2352x1568:
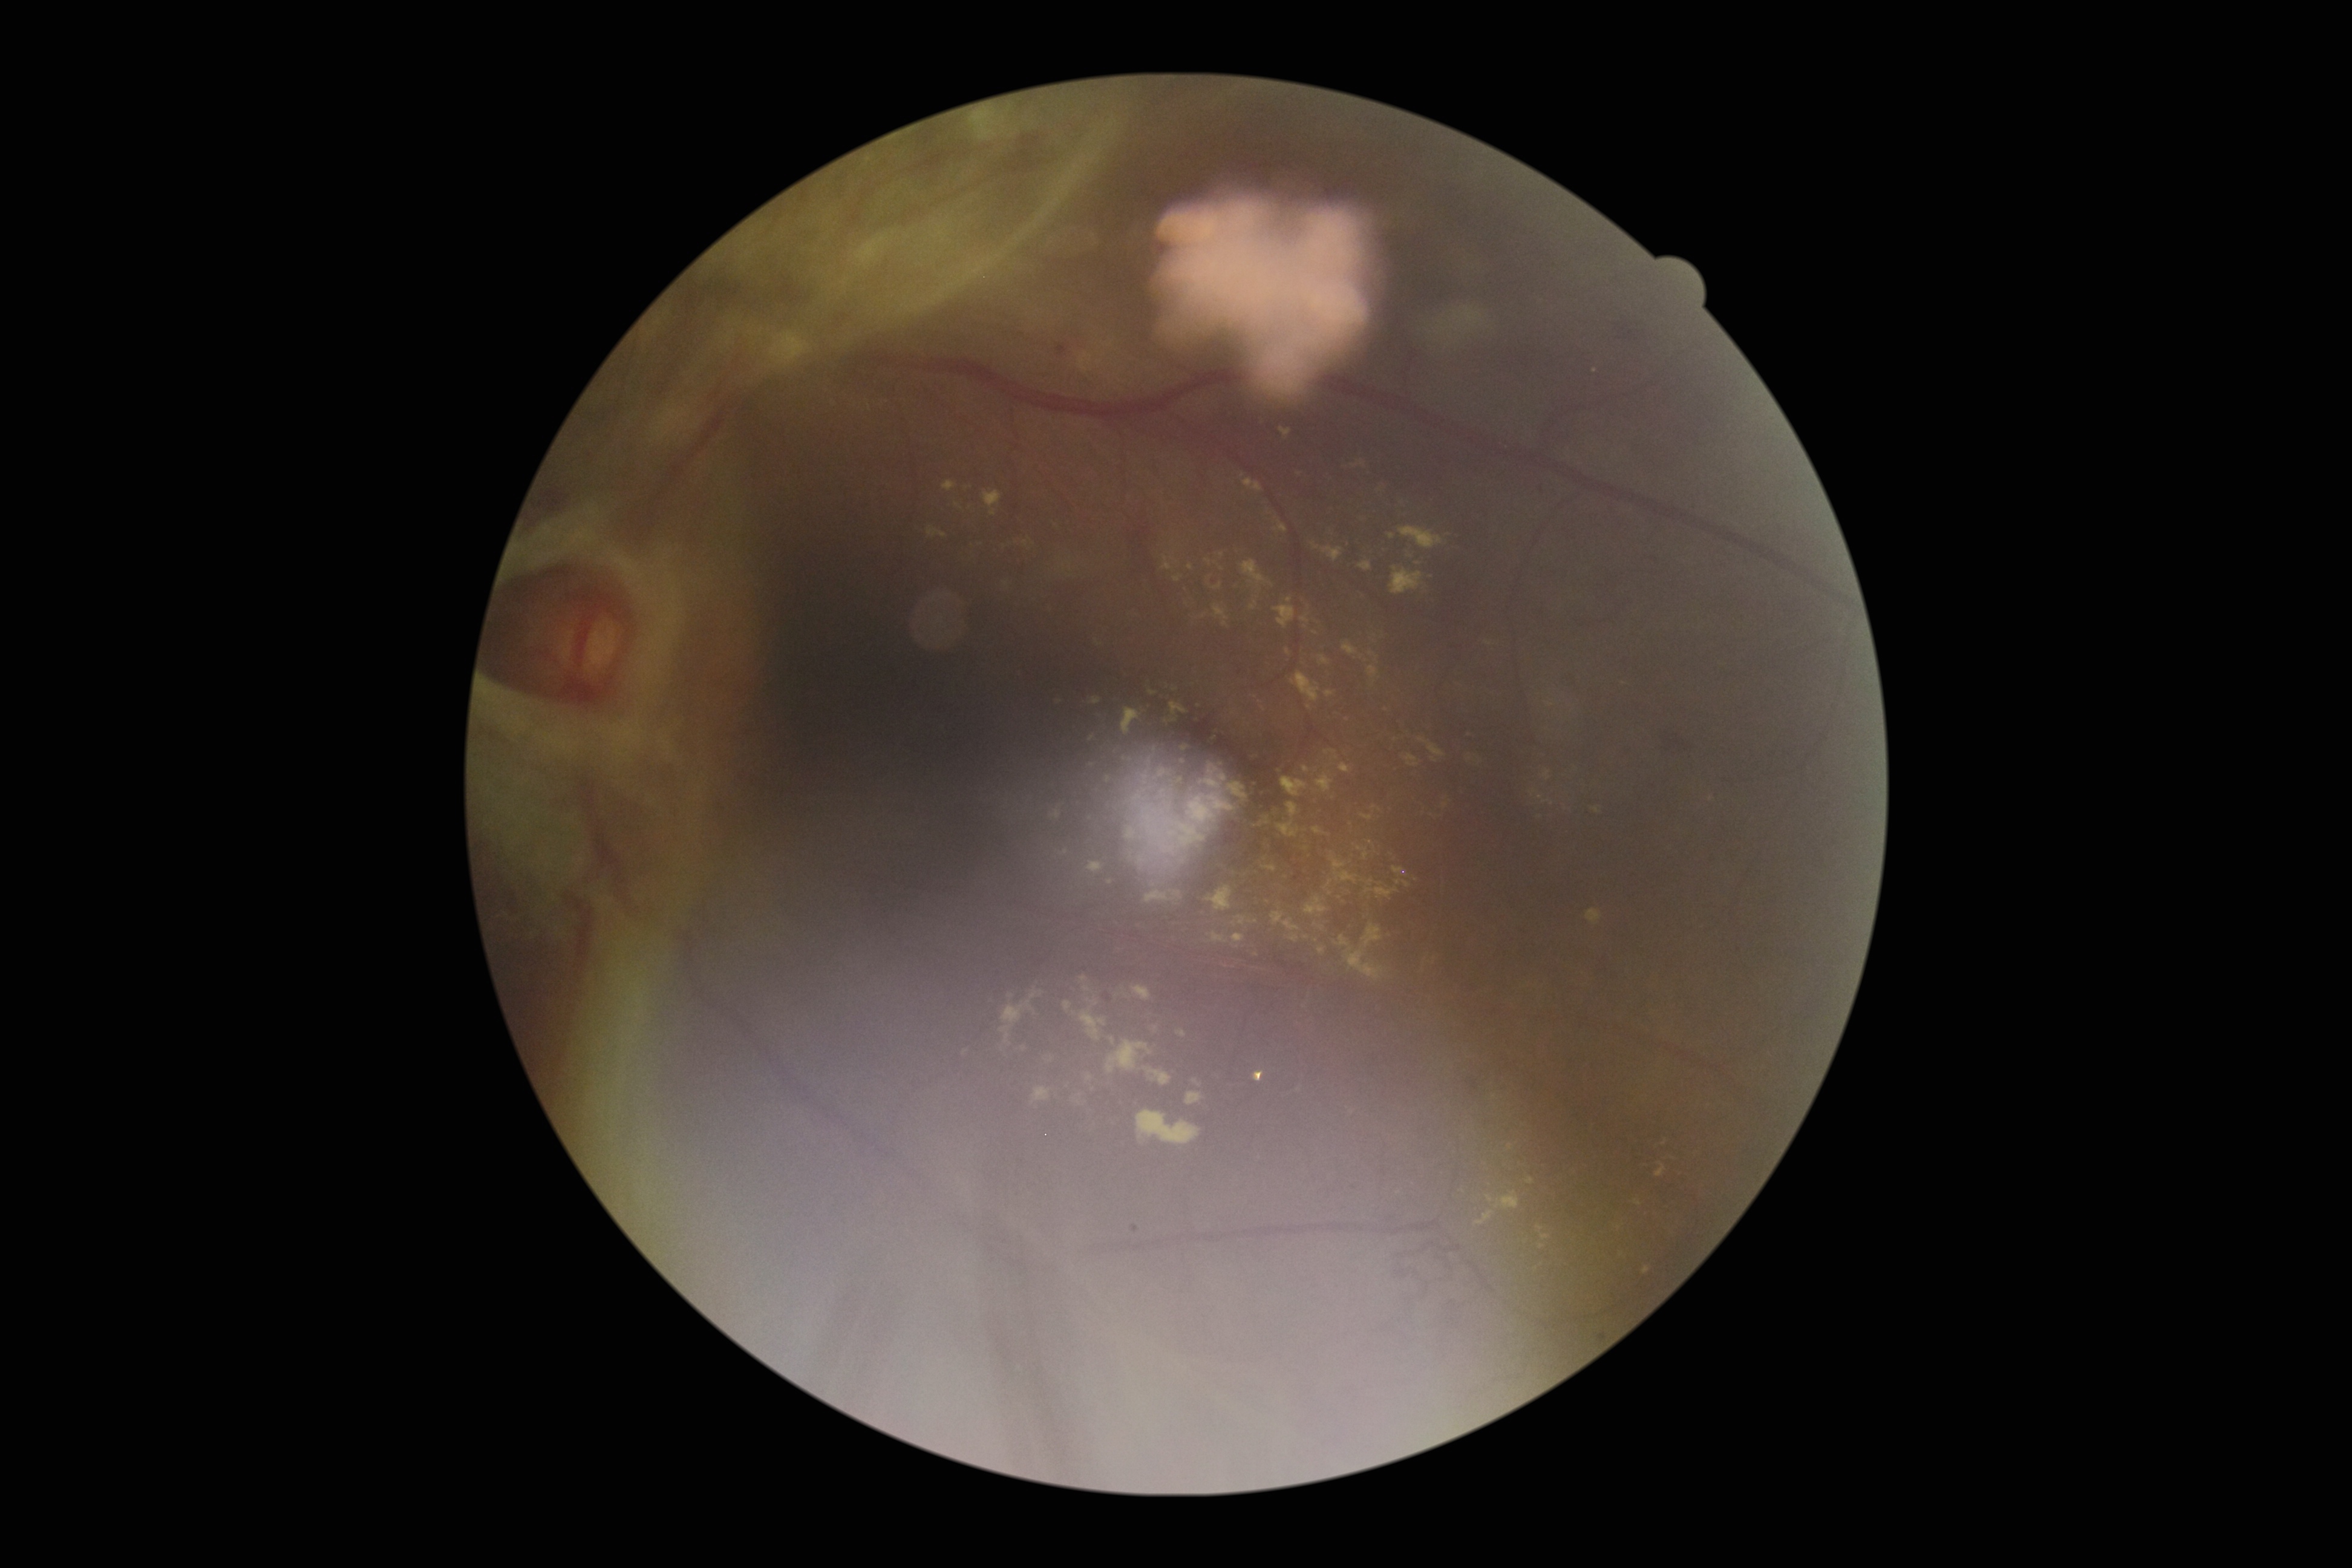
Retinopathy: grade 4 (PDR)
Lesions identified (partial list):
hard exudates (partial): Rect(1359, 562, 1373, 572); Rect(1642, 1266, 1650, 1275); Rect(1365, 675, 1375, 695); Rect(1125, 825, 1140, 841); Rect(1362, 803, 1380, 821); Rect(1156, 829, 1177, 857); Rect(1168, 857, 1190, 878); Rect(1074, 1097, 1086, 1115); Rect(1656, 1163, 1667, 1178); Rect(1354, 843, 1369, 868); Rect(1541, 1236, 1550, 1241); Rect(1324, 685, 1334, 695); Rect(1313, 943, 1325, 953); Rect(1365, 880, 1399, 903); Rect(1281, 766, 1316, 803)
Smaller hard exudates around 1290/600; 1510/1147; 1619/1228